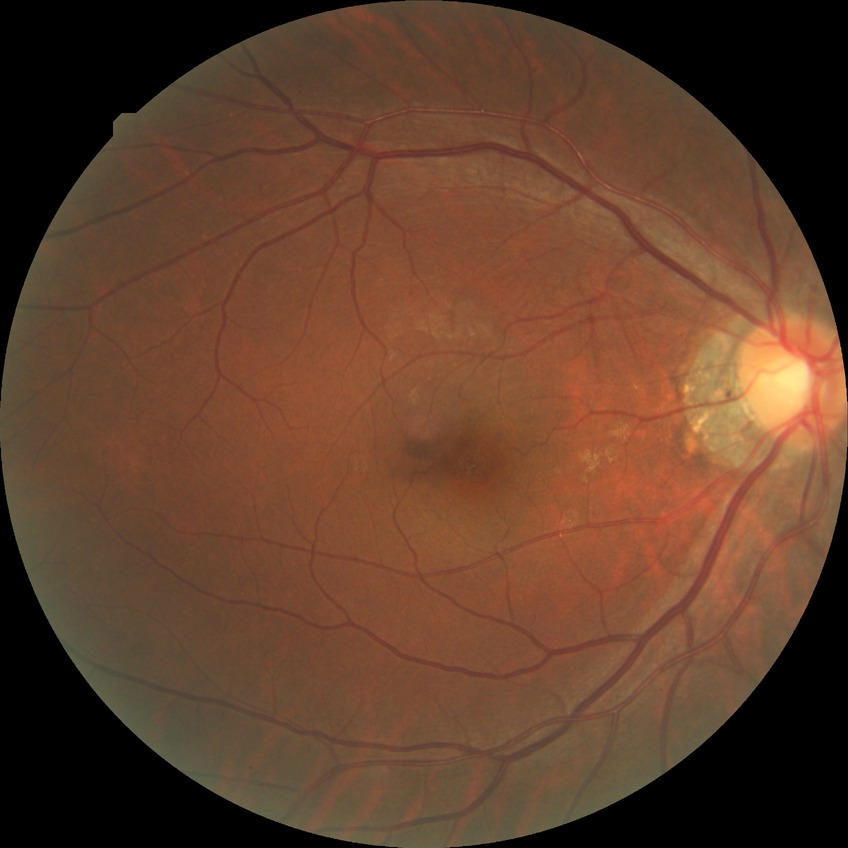 Diabetic retinopathy (DR): no diabetic retinopathy (NDR).